1932x1932; color fundus image.
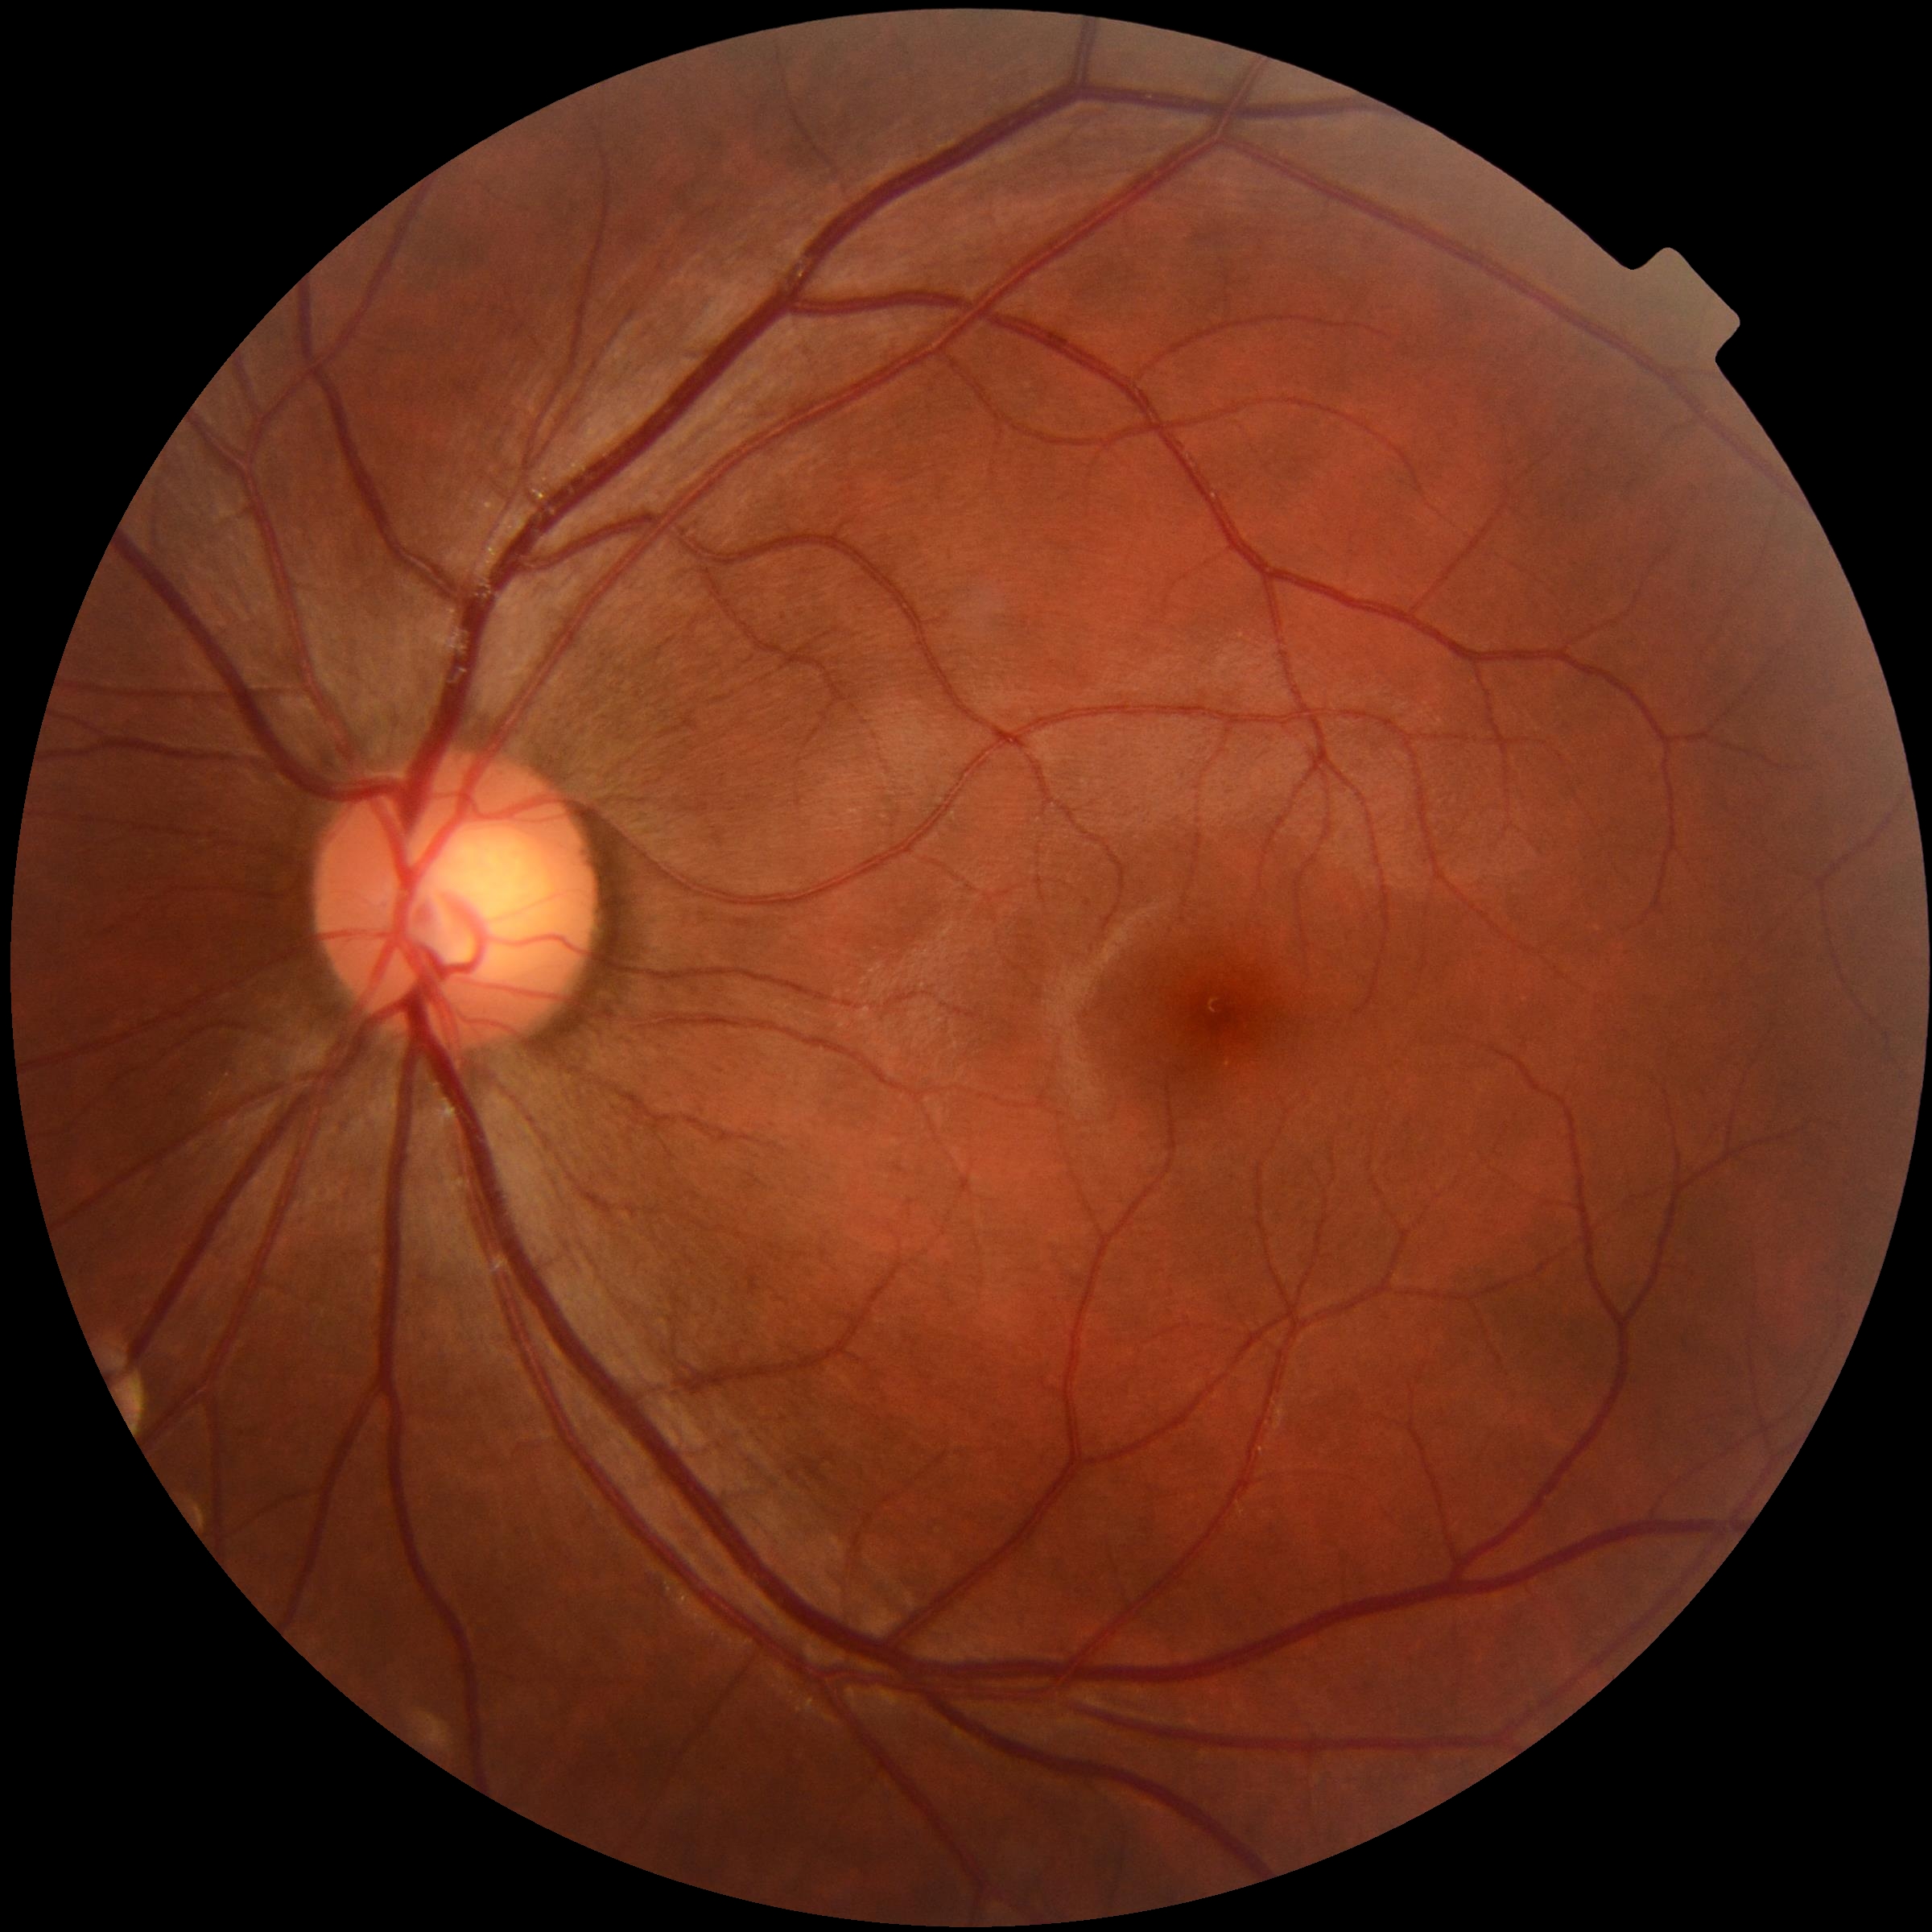
{"dr_grade": "0", "dr_impression": "no signs of DR"}